FOV: 45 degrees. 2048x1536px.
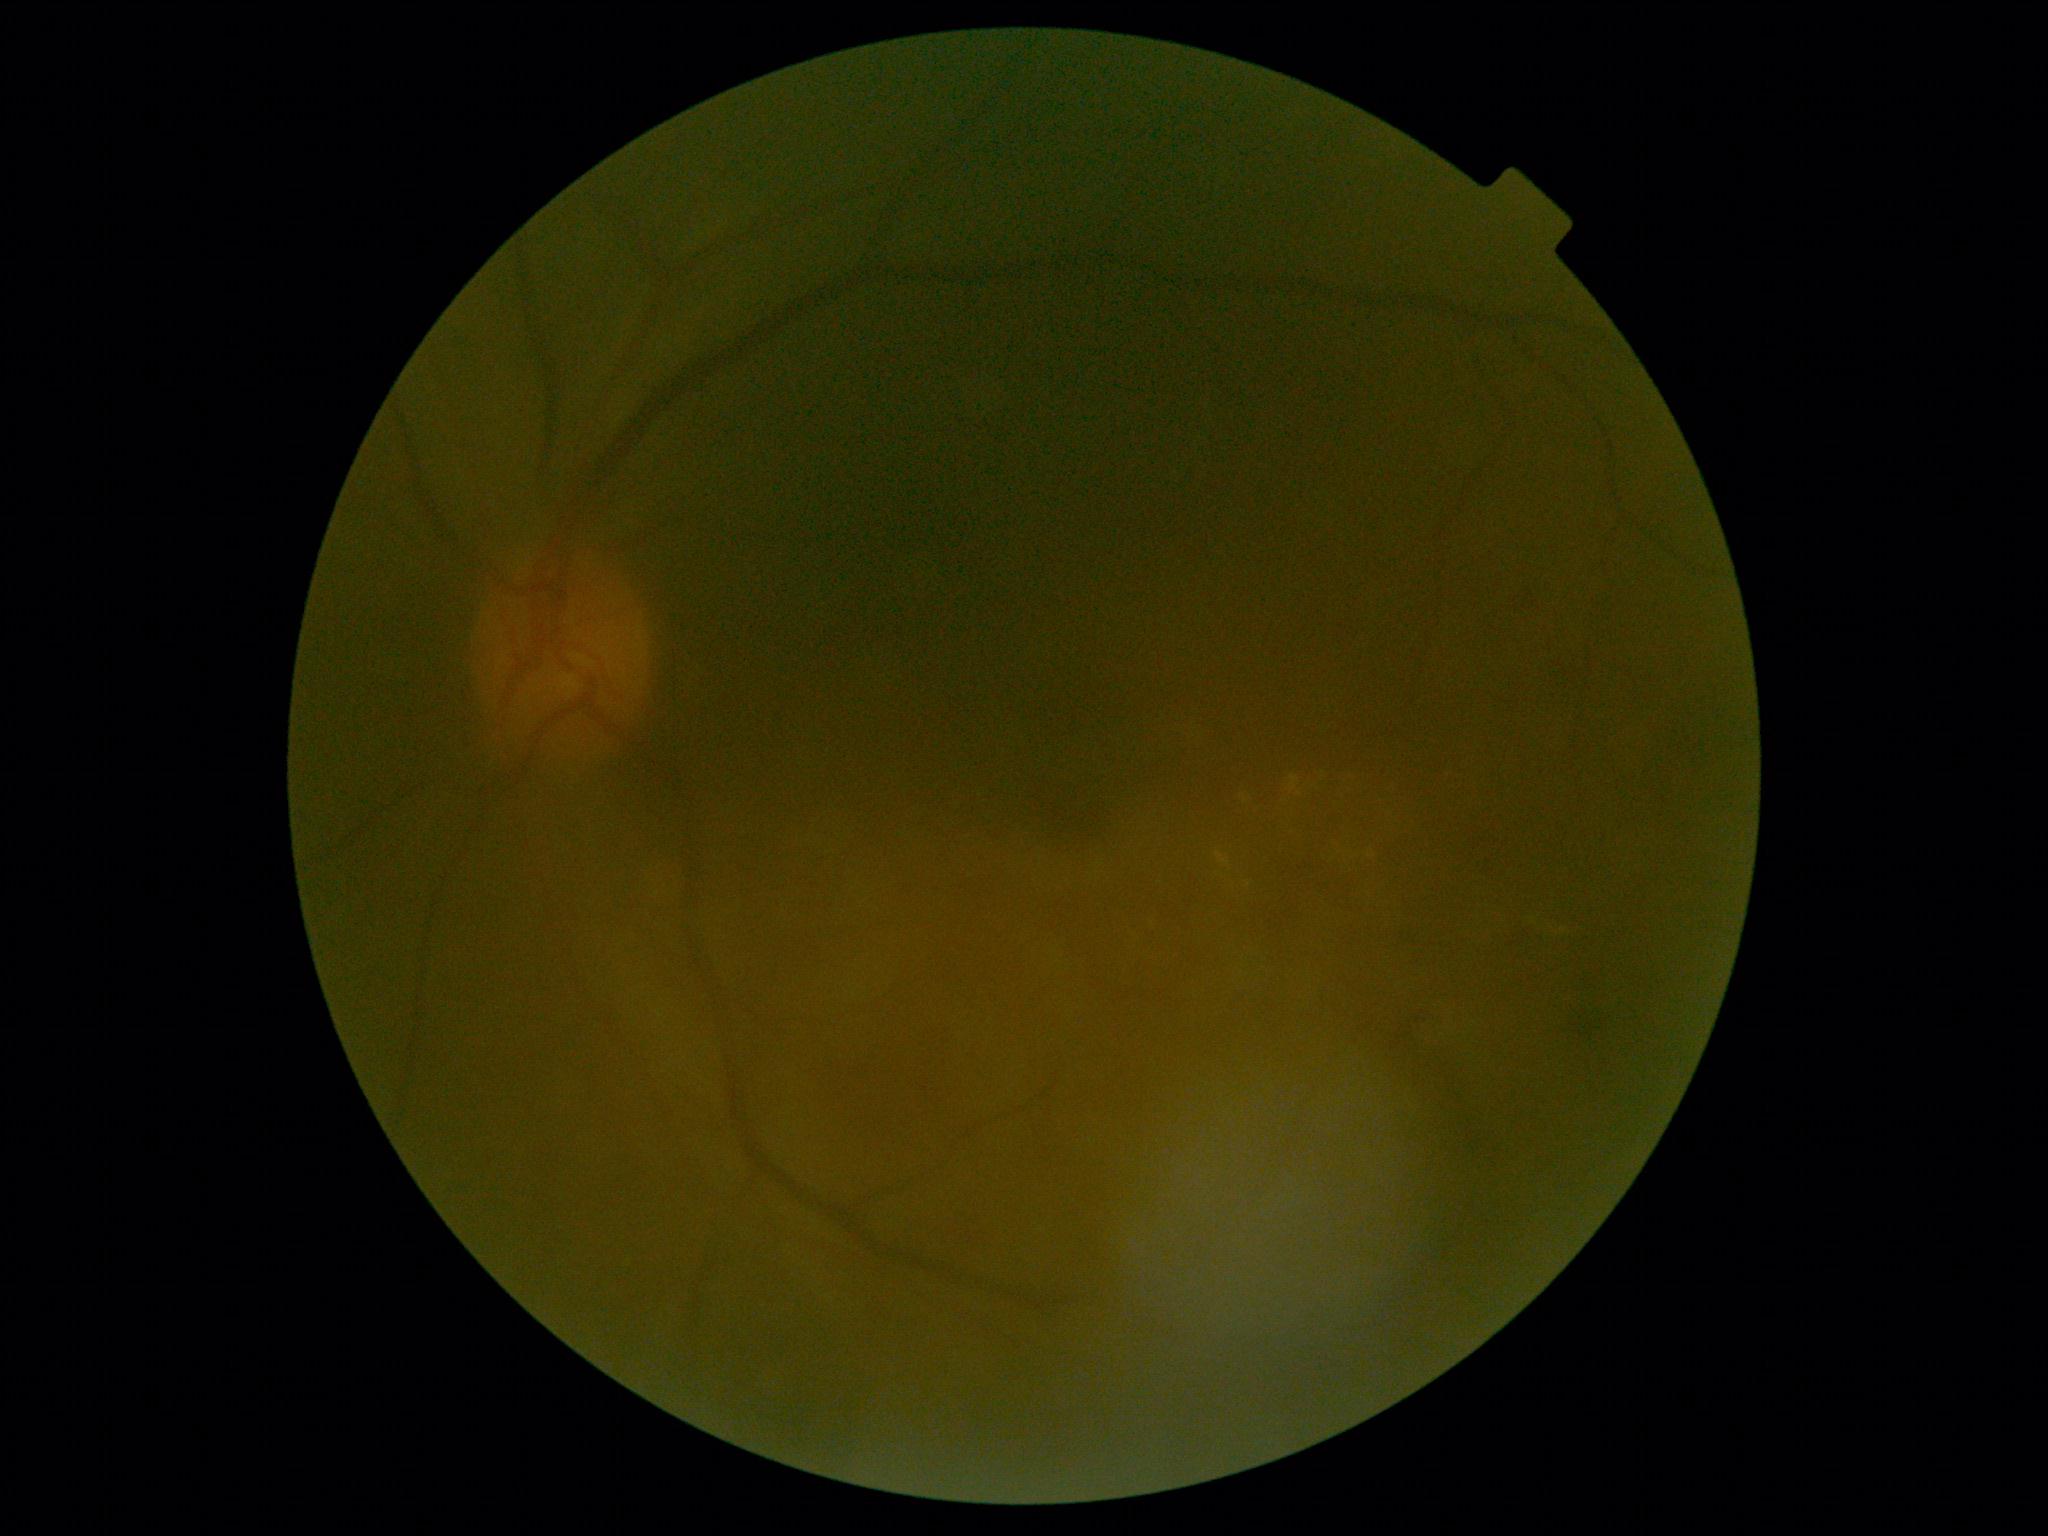

DR = 2 — more than just microaneurysms but less than severe NPDR.